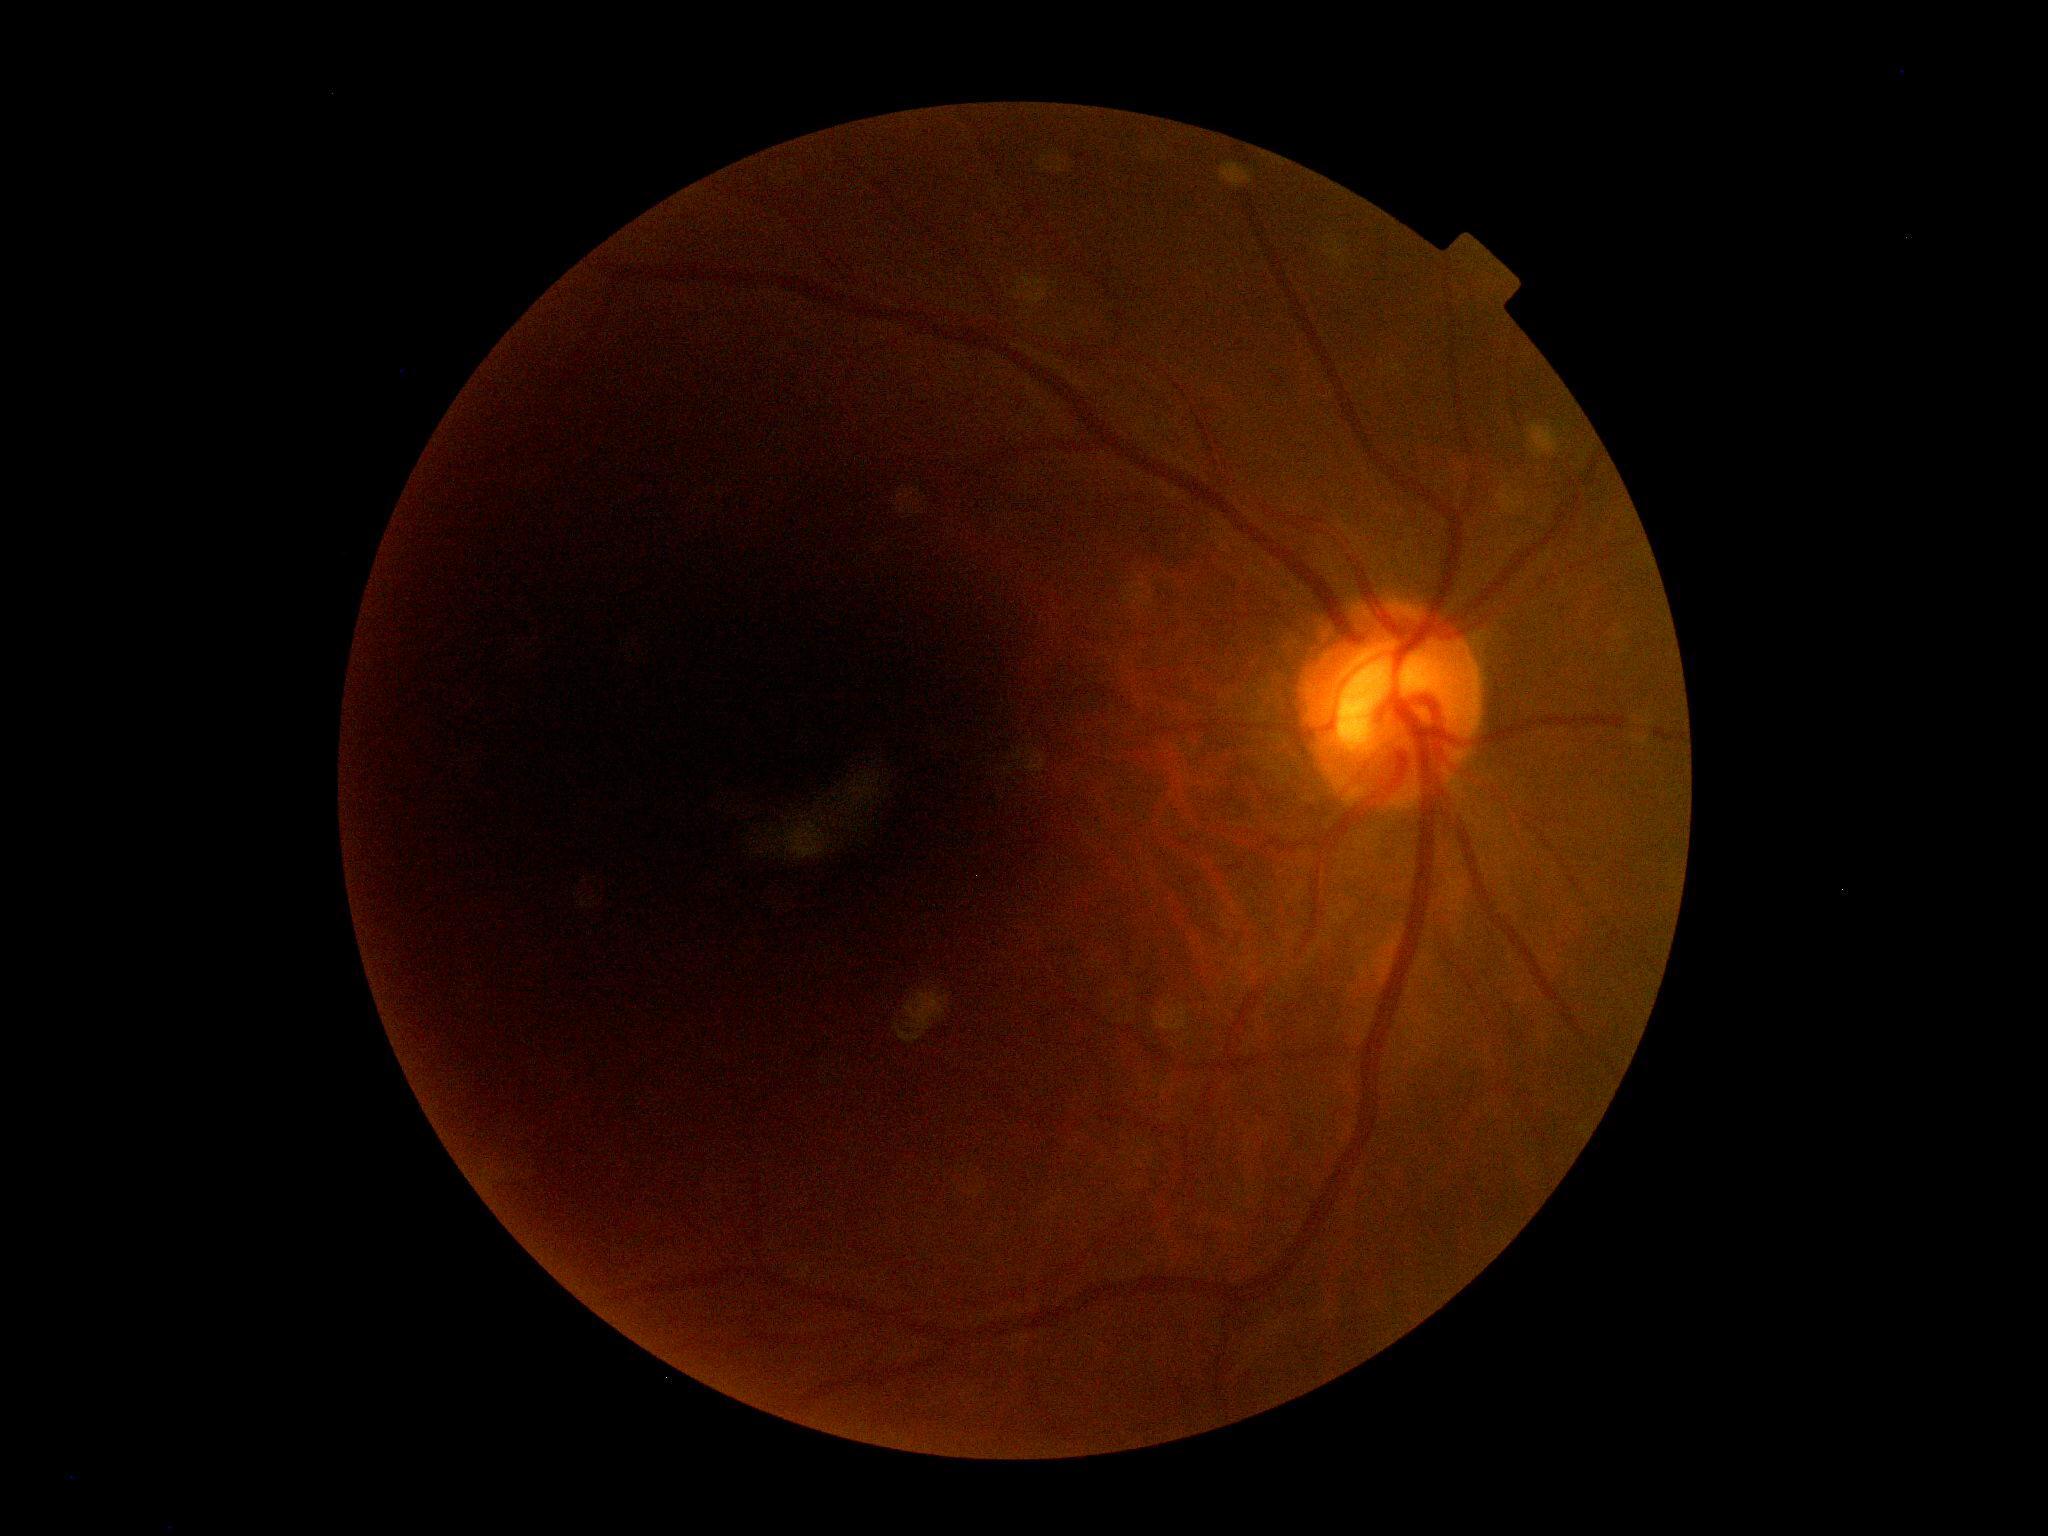
Diabetic retinopathy (DR) is no apparent diabetic retinopathy (grade 0).